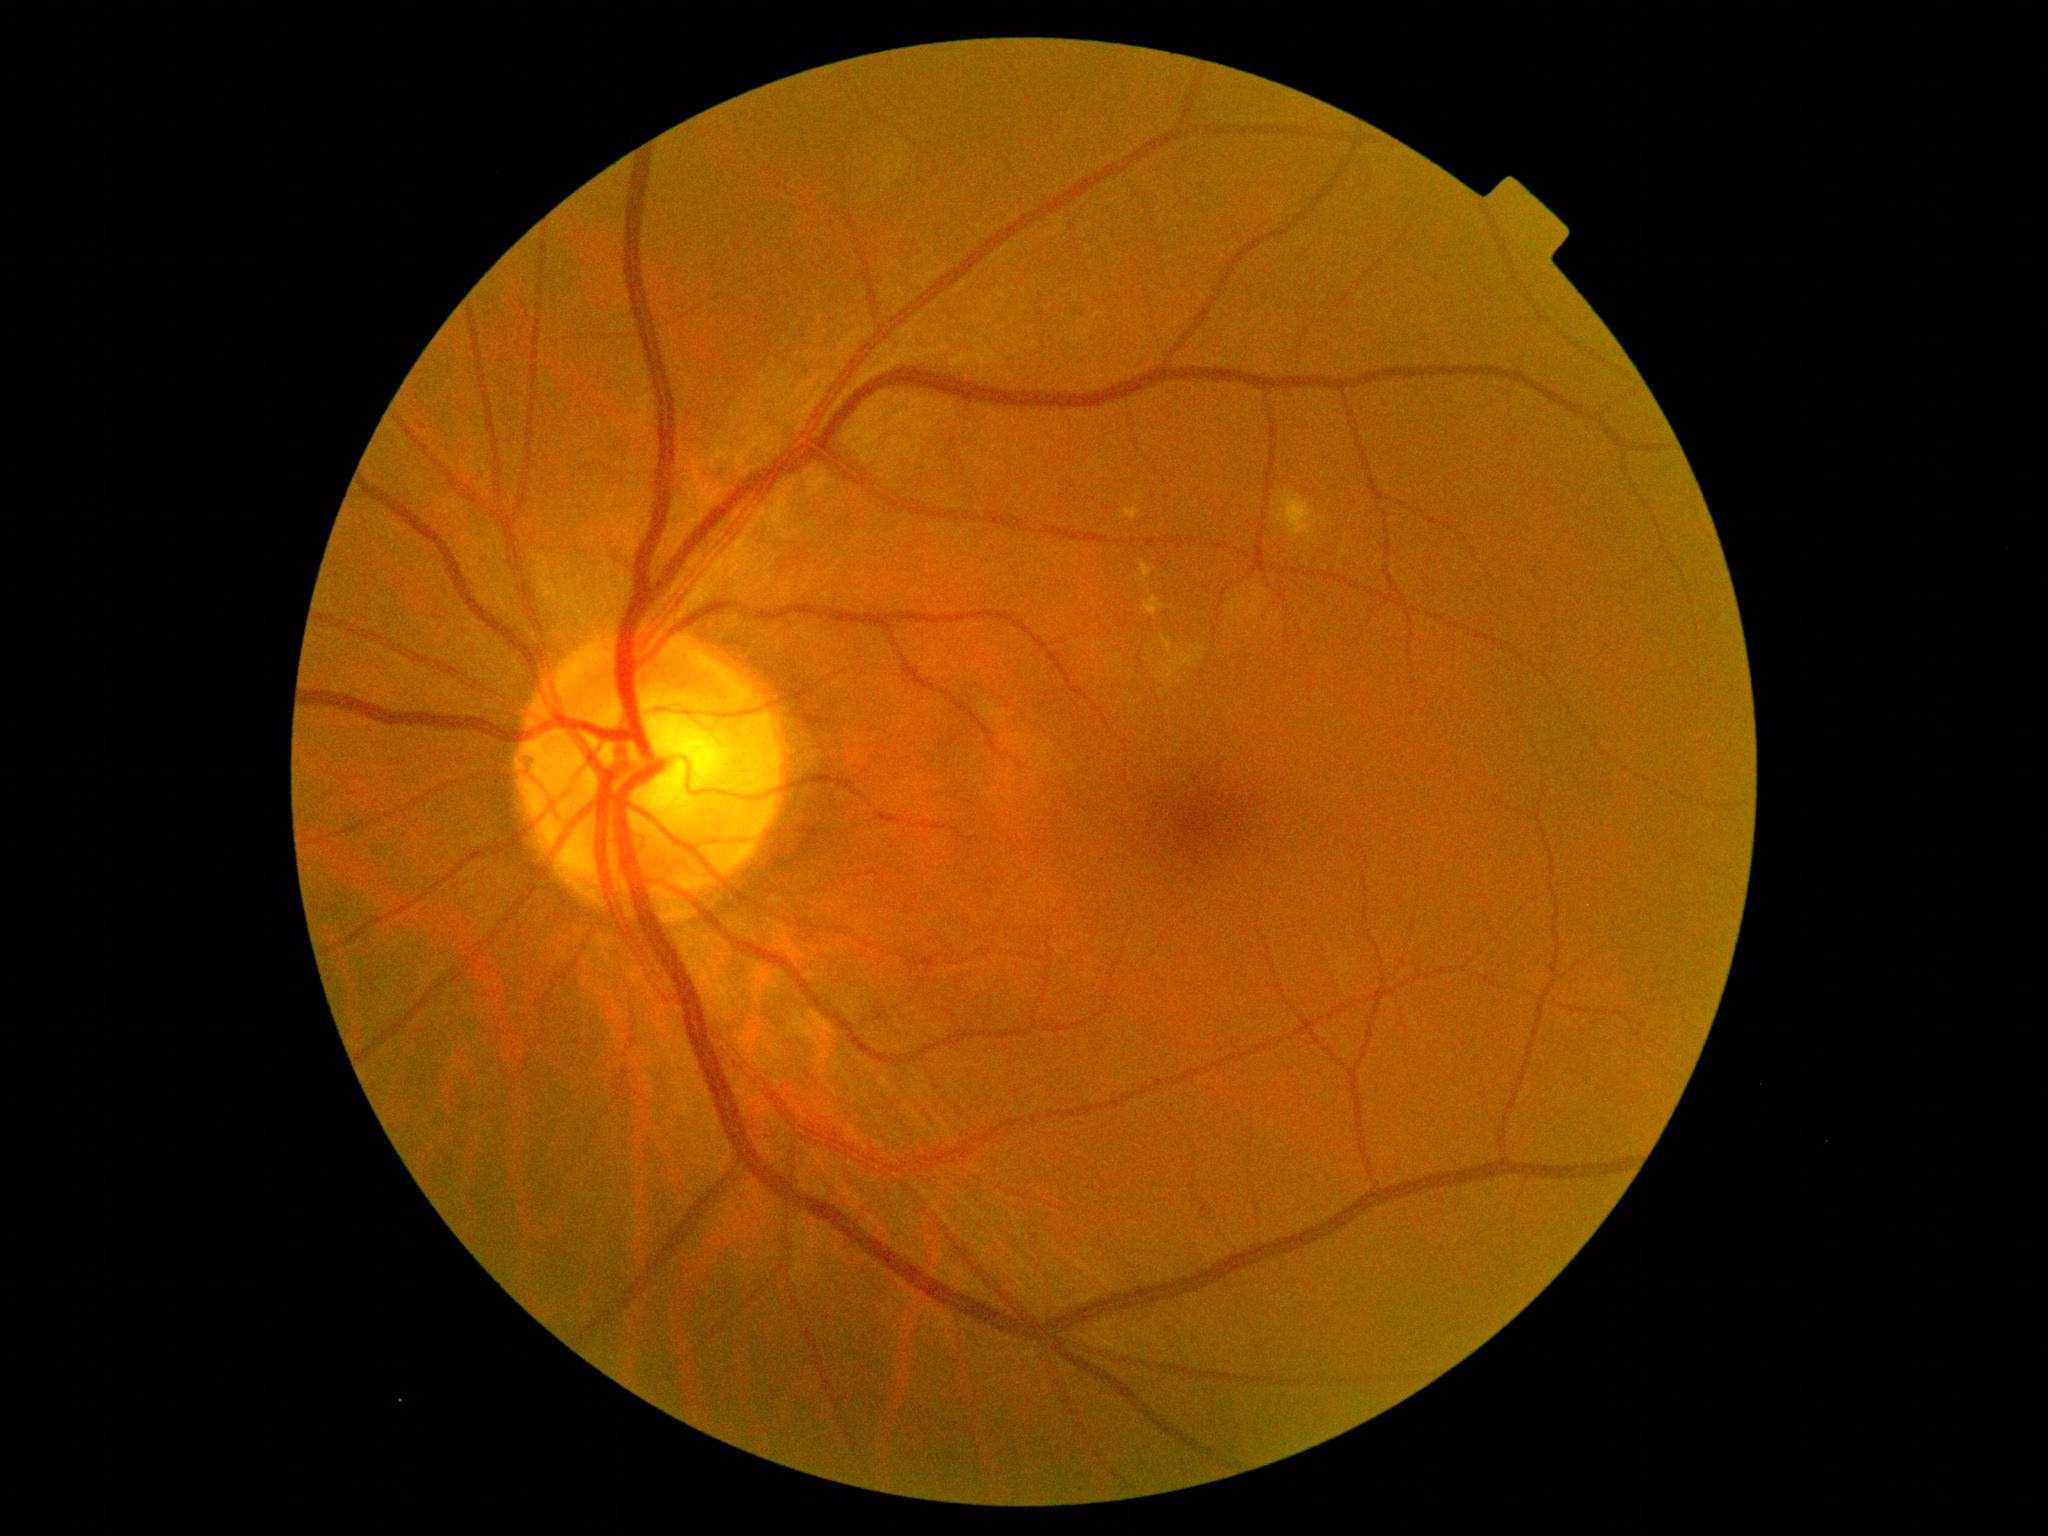

DR is moderate non-proliferative diabetic retinopathy (grade 2).